Infant wide-field fundus photograph
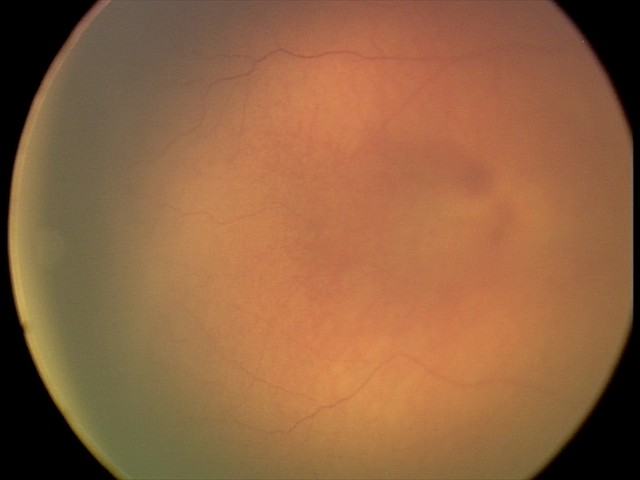

Impression: physiological retinal finding.